1240 x 1240 pixels; captured with the Phoenix ICON (100° field of view); pediatric wide-field fundus photograph.
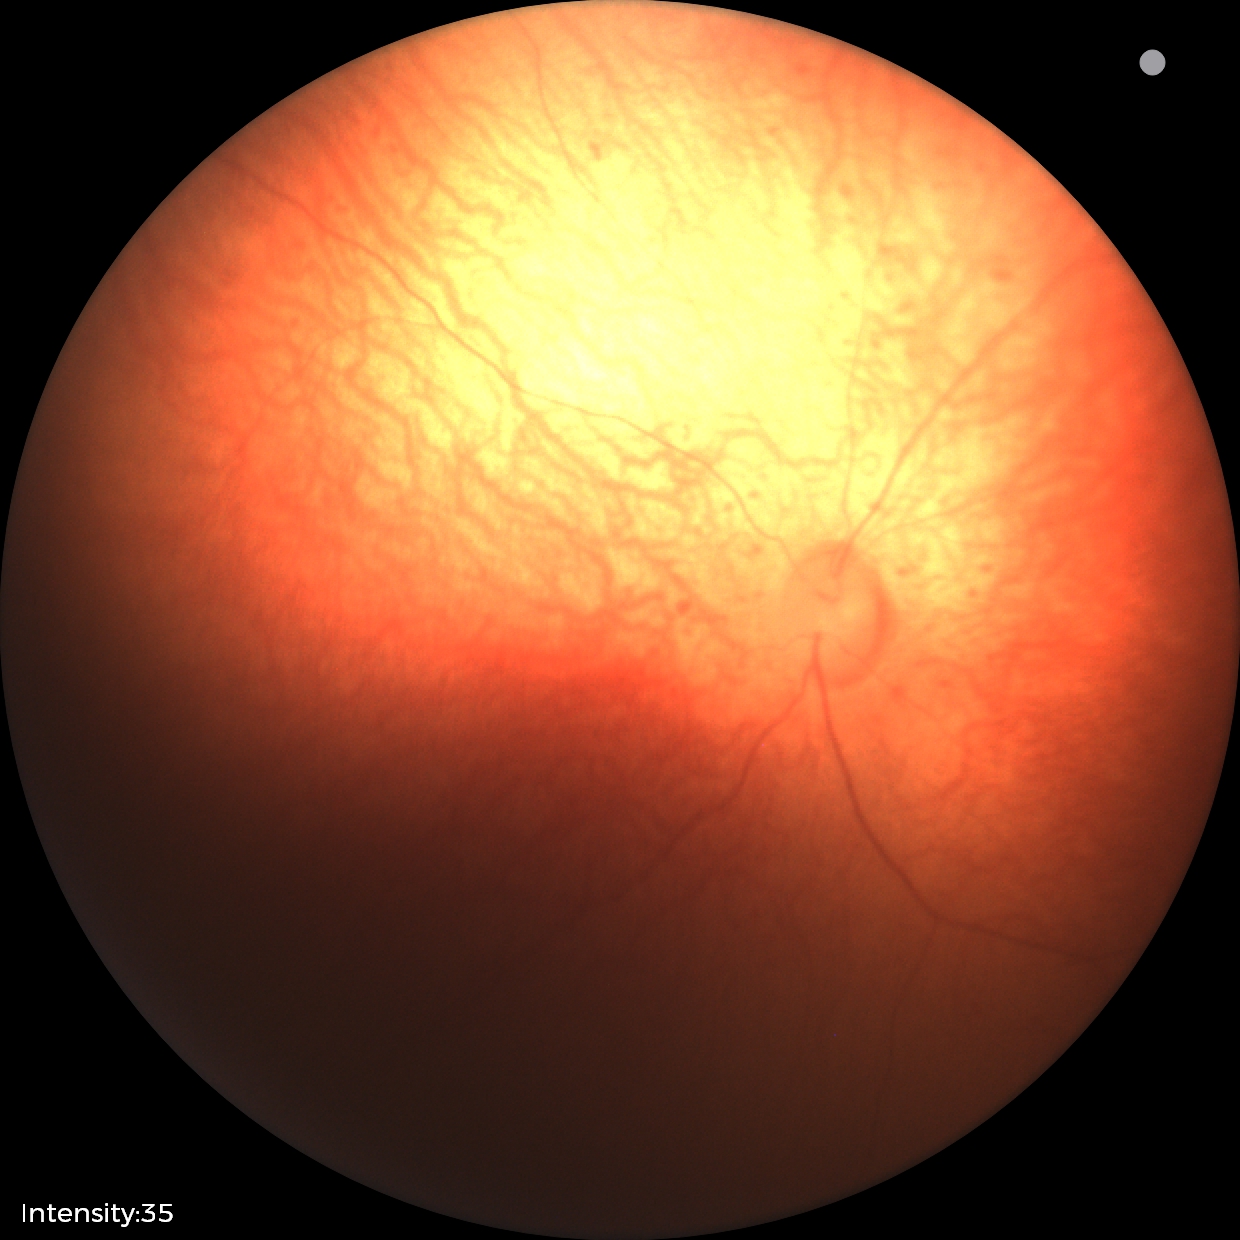
Examination with physiological retinal findings.